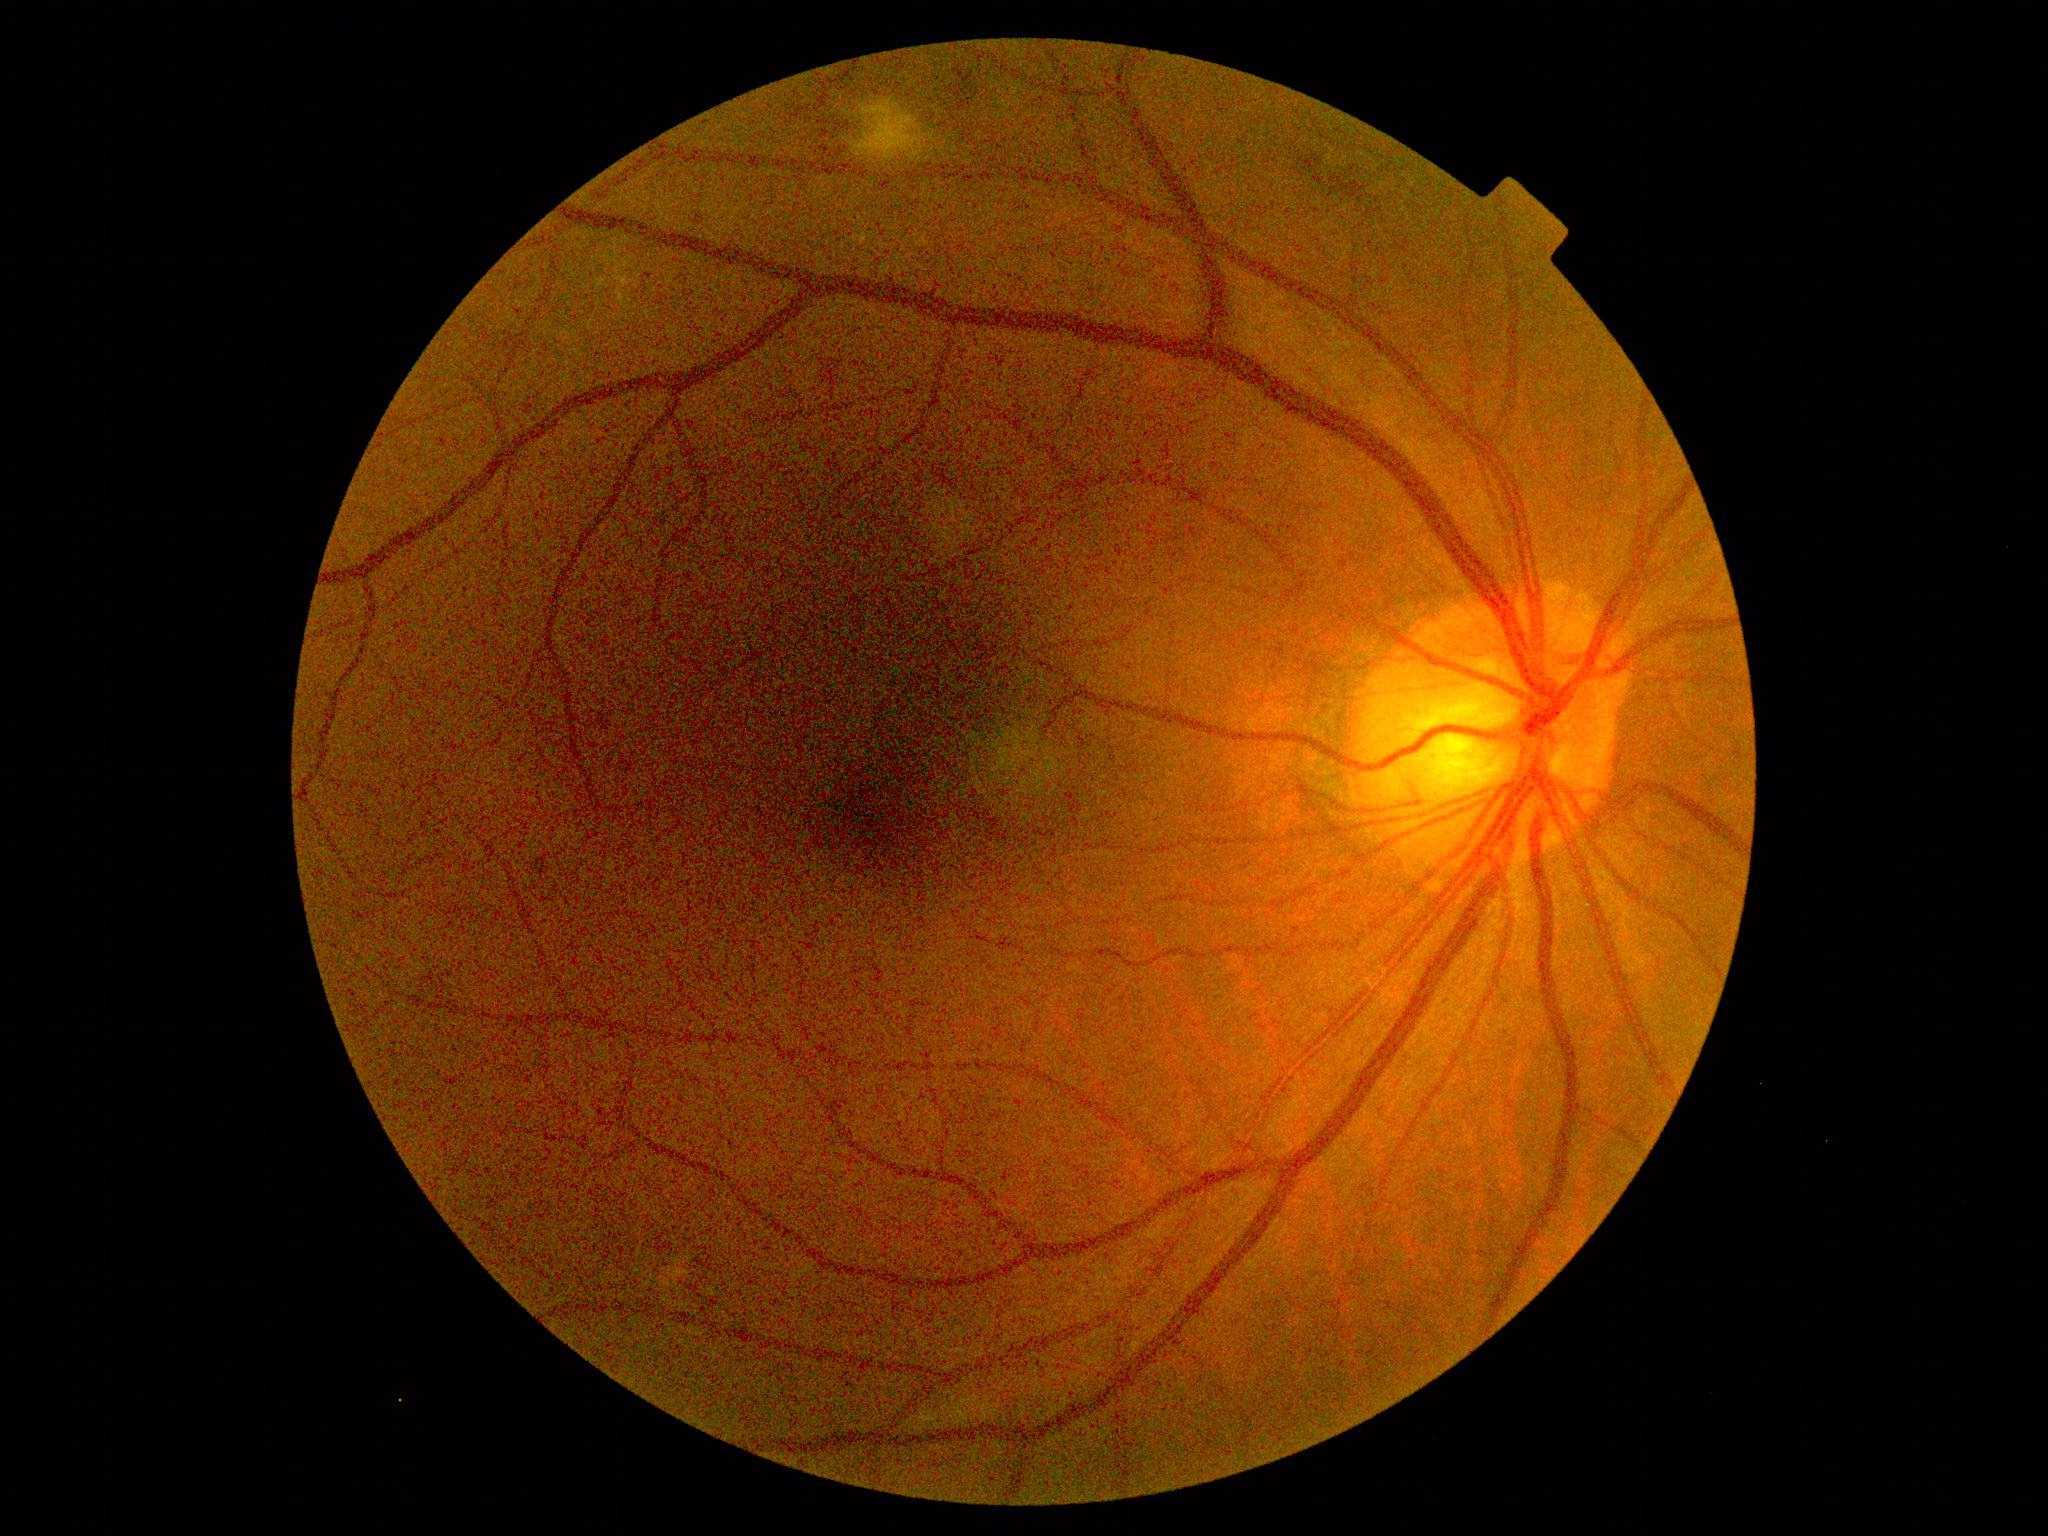 Retinopathy: 2/4.